848x848px
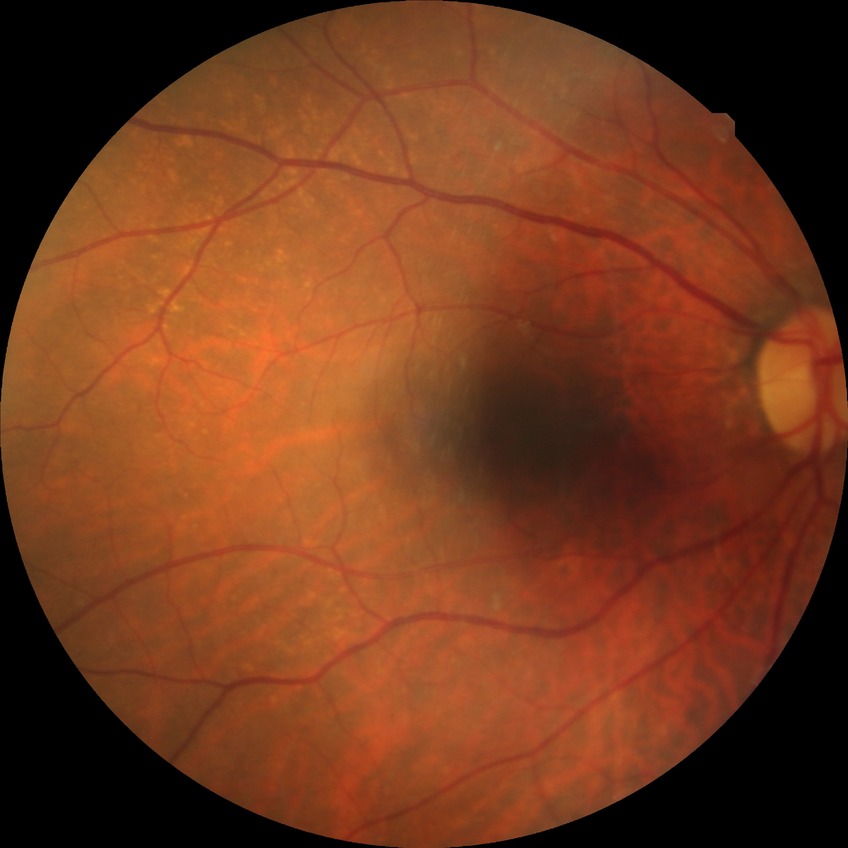

  davis_grade: no diabetic retinopathy (NDR)